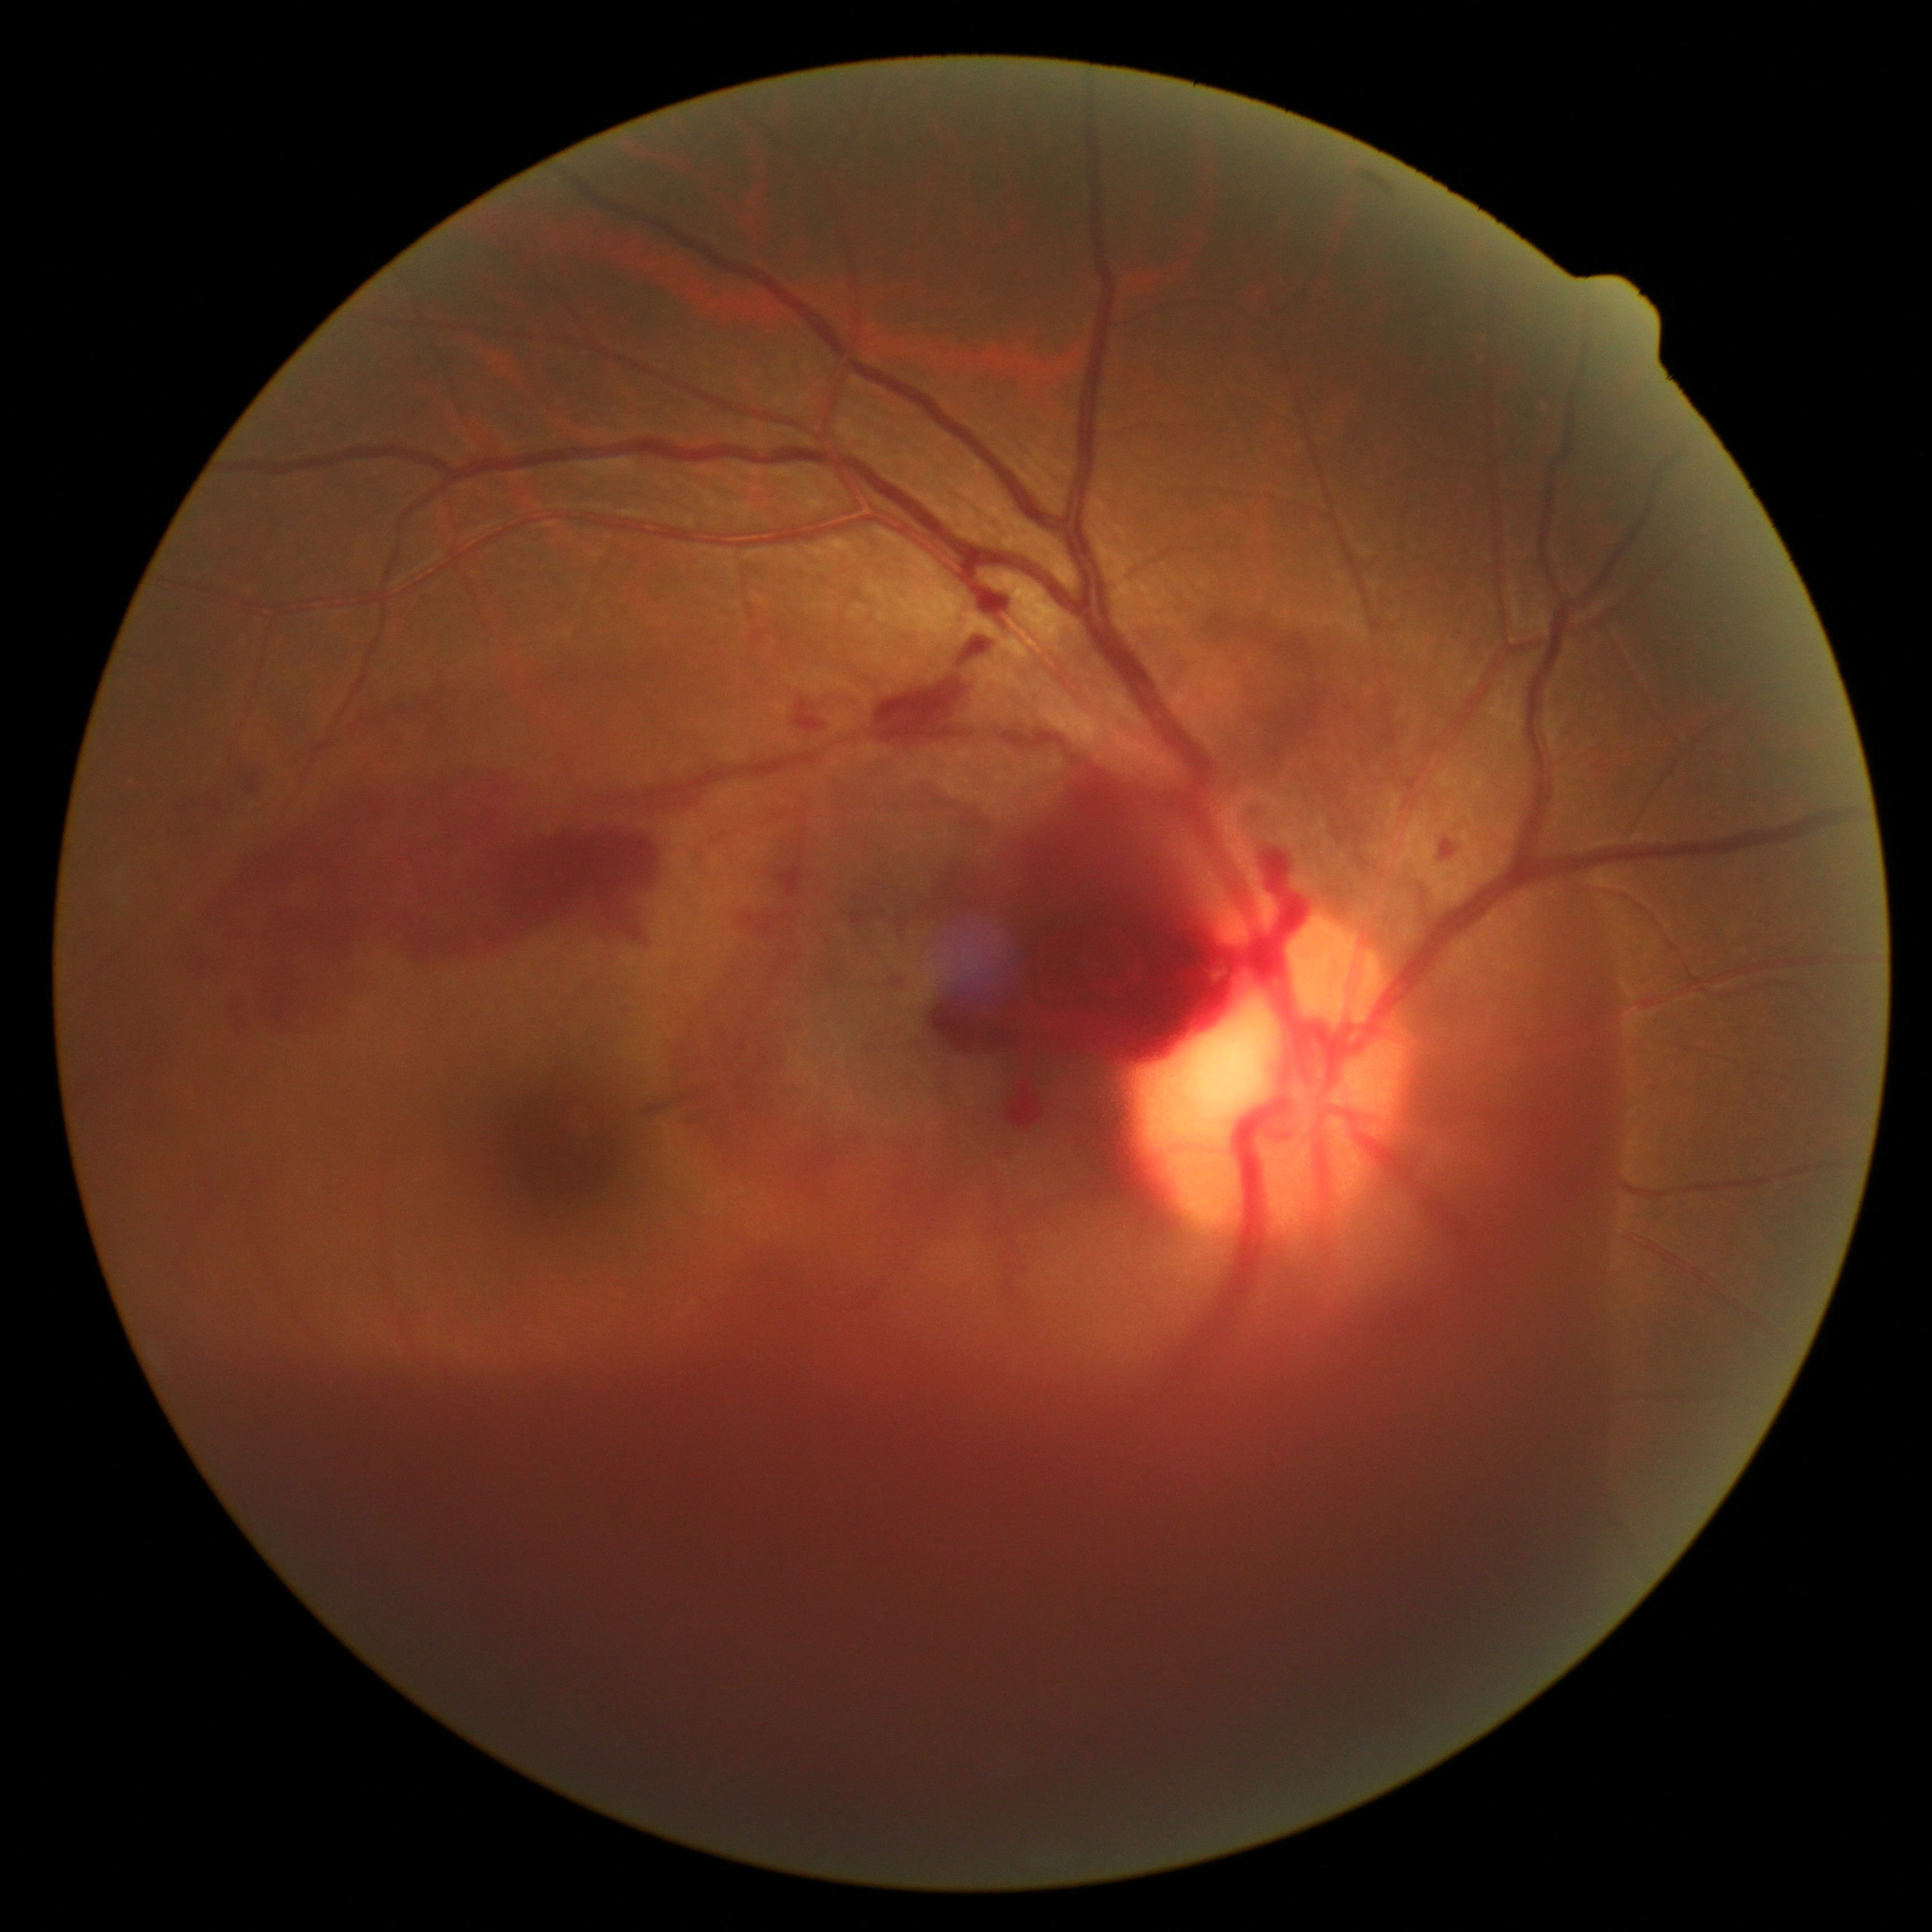
Retinopathy grade is PDR (4).